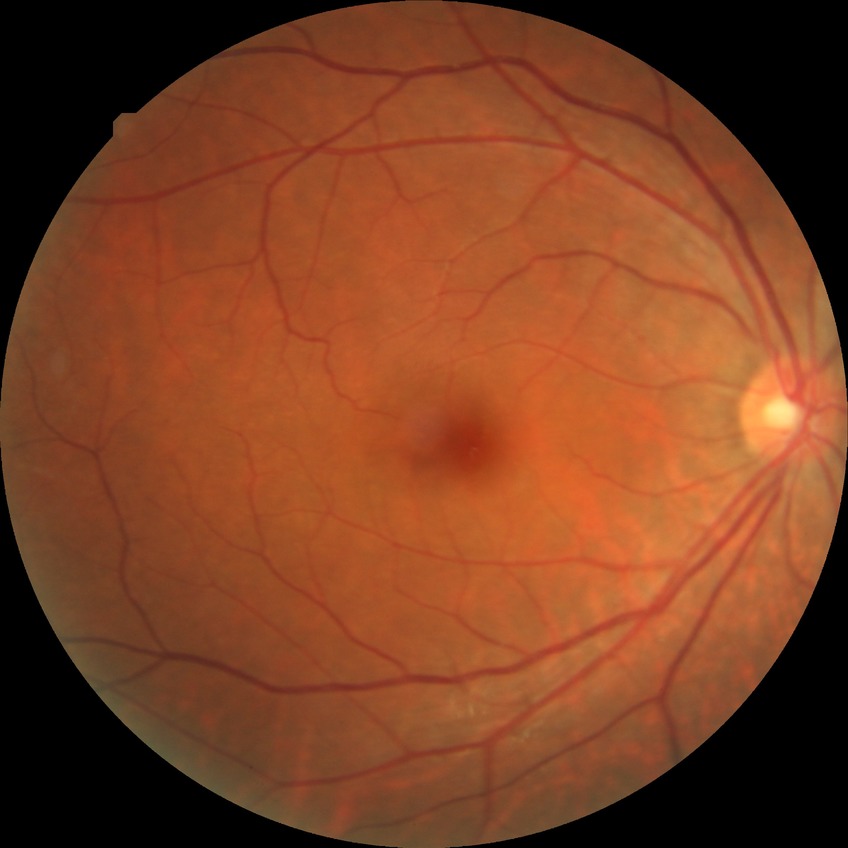
Annotations:
– retinopathy grade: no diabetic retinopathy